Image size 848x848:
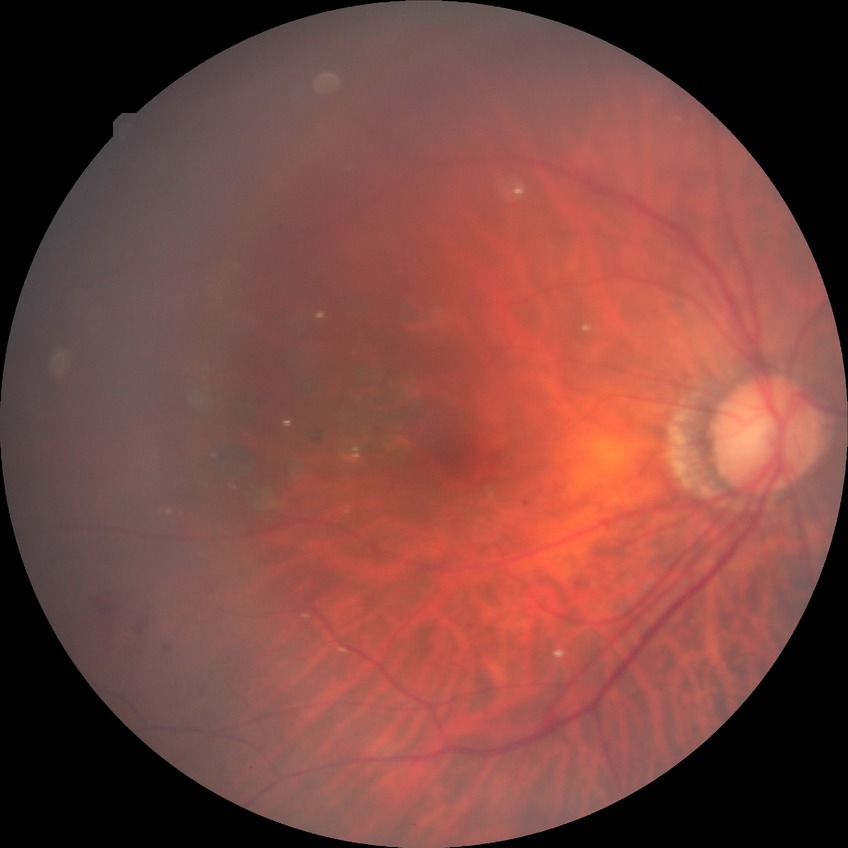
Diabetic retinopathy severity: proliferative diabetic retinopathy.